Fundus photo; camera: Nidek AFC-330; optic disc-centered crop: 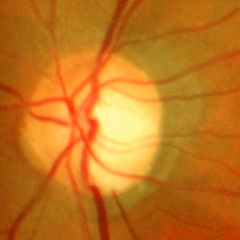 Diagnosis = early glaucoma. Defined as glaucomatous retinal nerve fiber layer defects on red-free fundus photography without visual field defects.